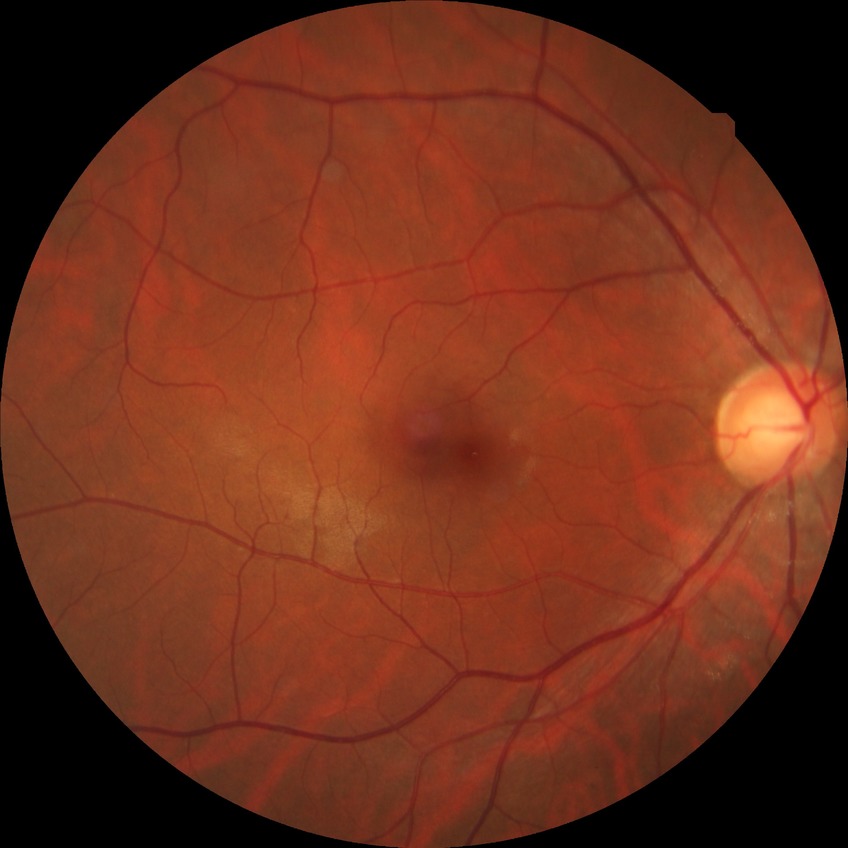

davis_grade: NDR (no diabetic retinopathy)